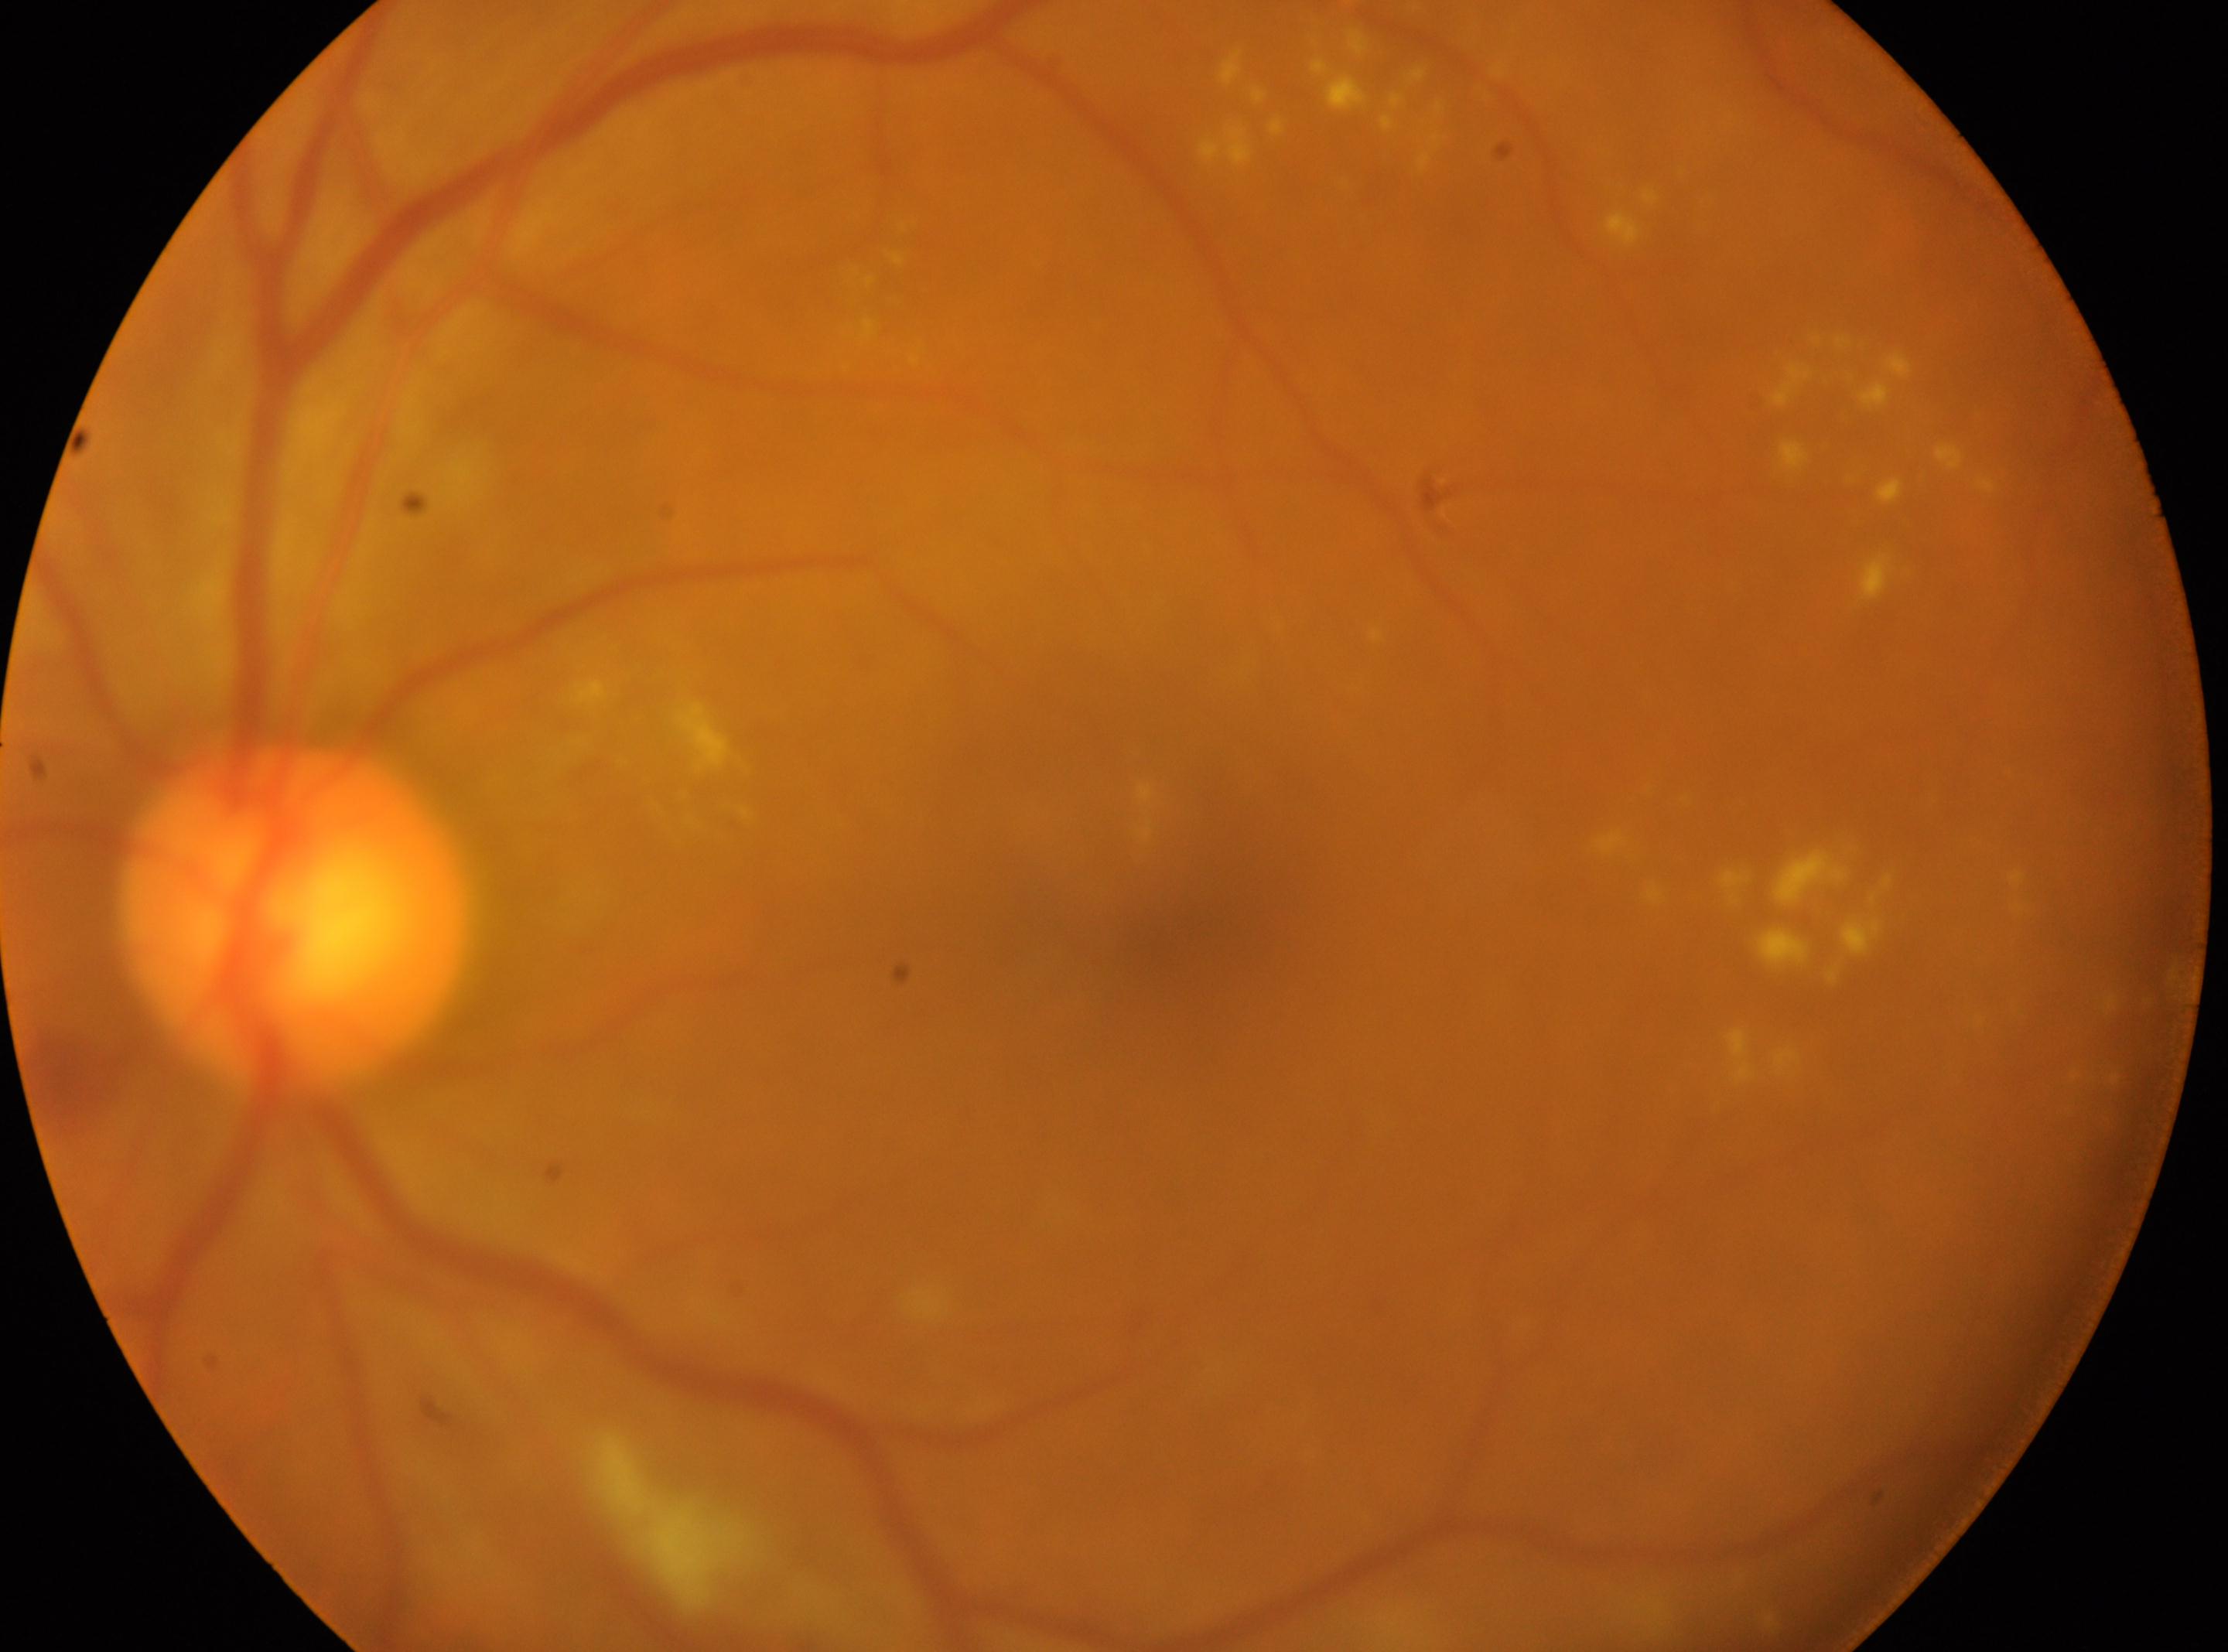

DR class: non-proliferative diabetic retinopathy.
Optic disk located at x=292, y=916.
DR severity: 2.
Foveal center: x=1156, y=916.
Eye: left.